Acquired with a NIDEK AFC-230. 45 degree fundus photograph. No pharmacologic dilation — 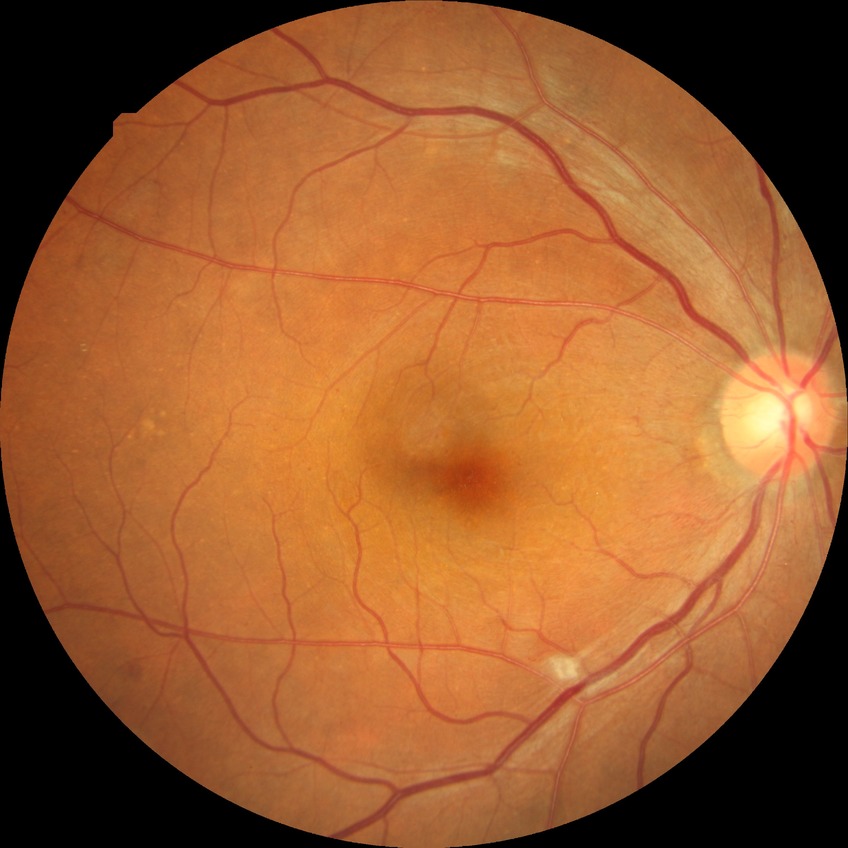

Diabetic retinopathy severity: pre-proliferative diabetic retinopathy.